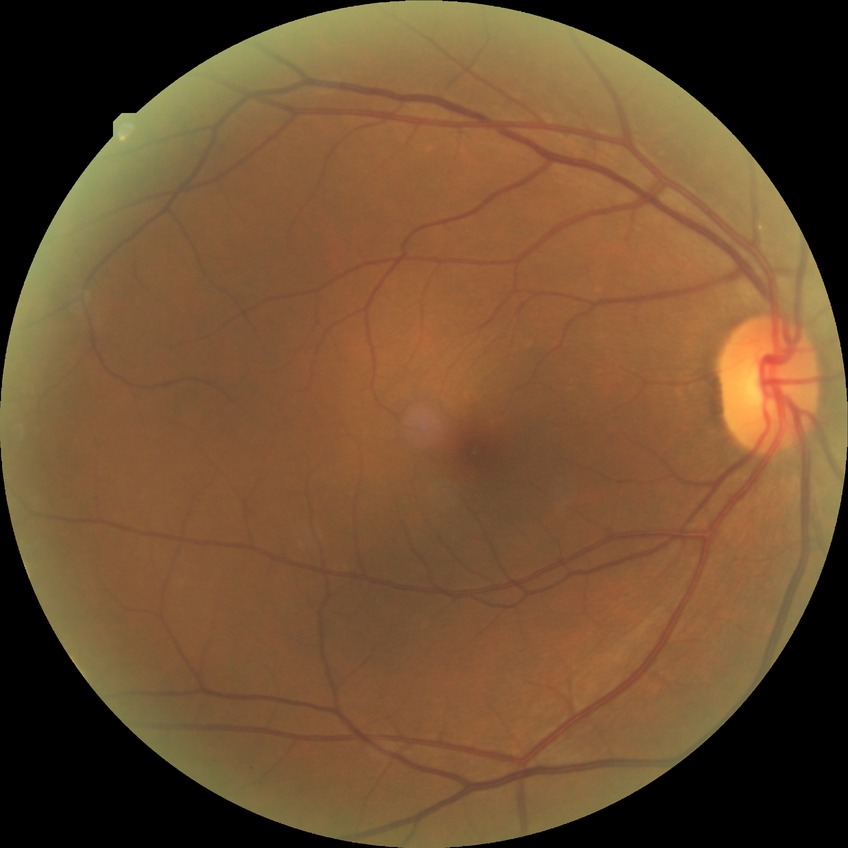
diabetic retinopathy stage@no diabetic retinopathy.